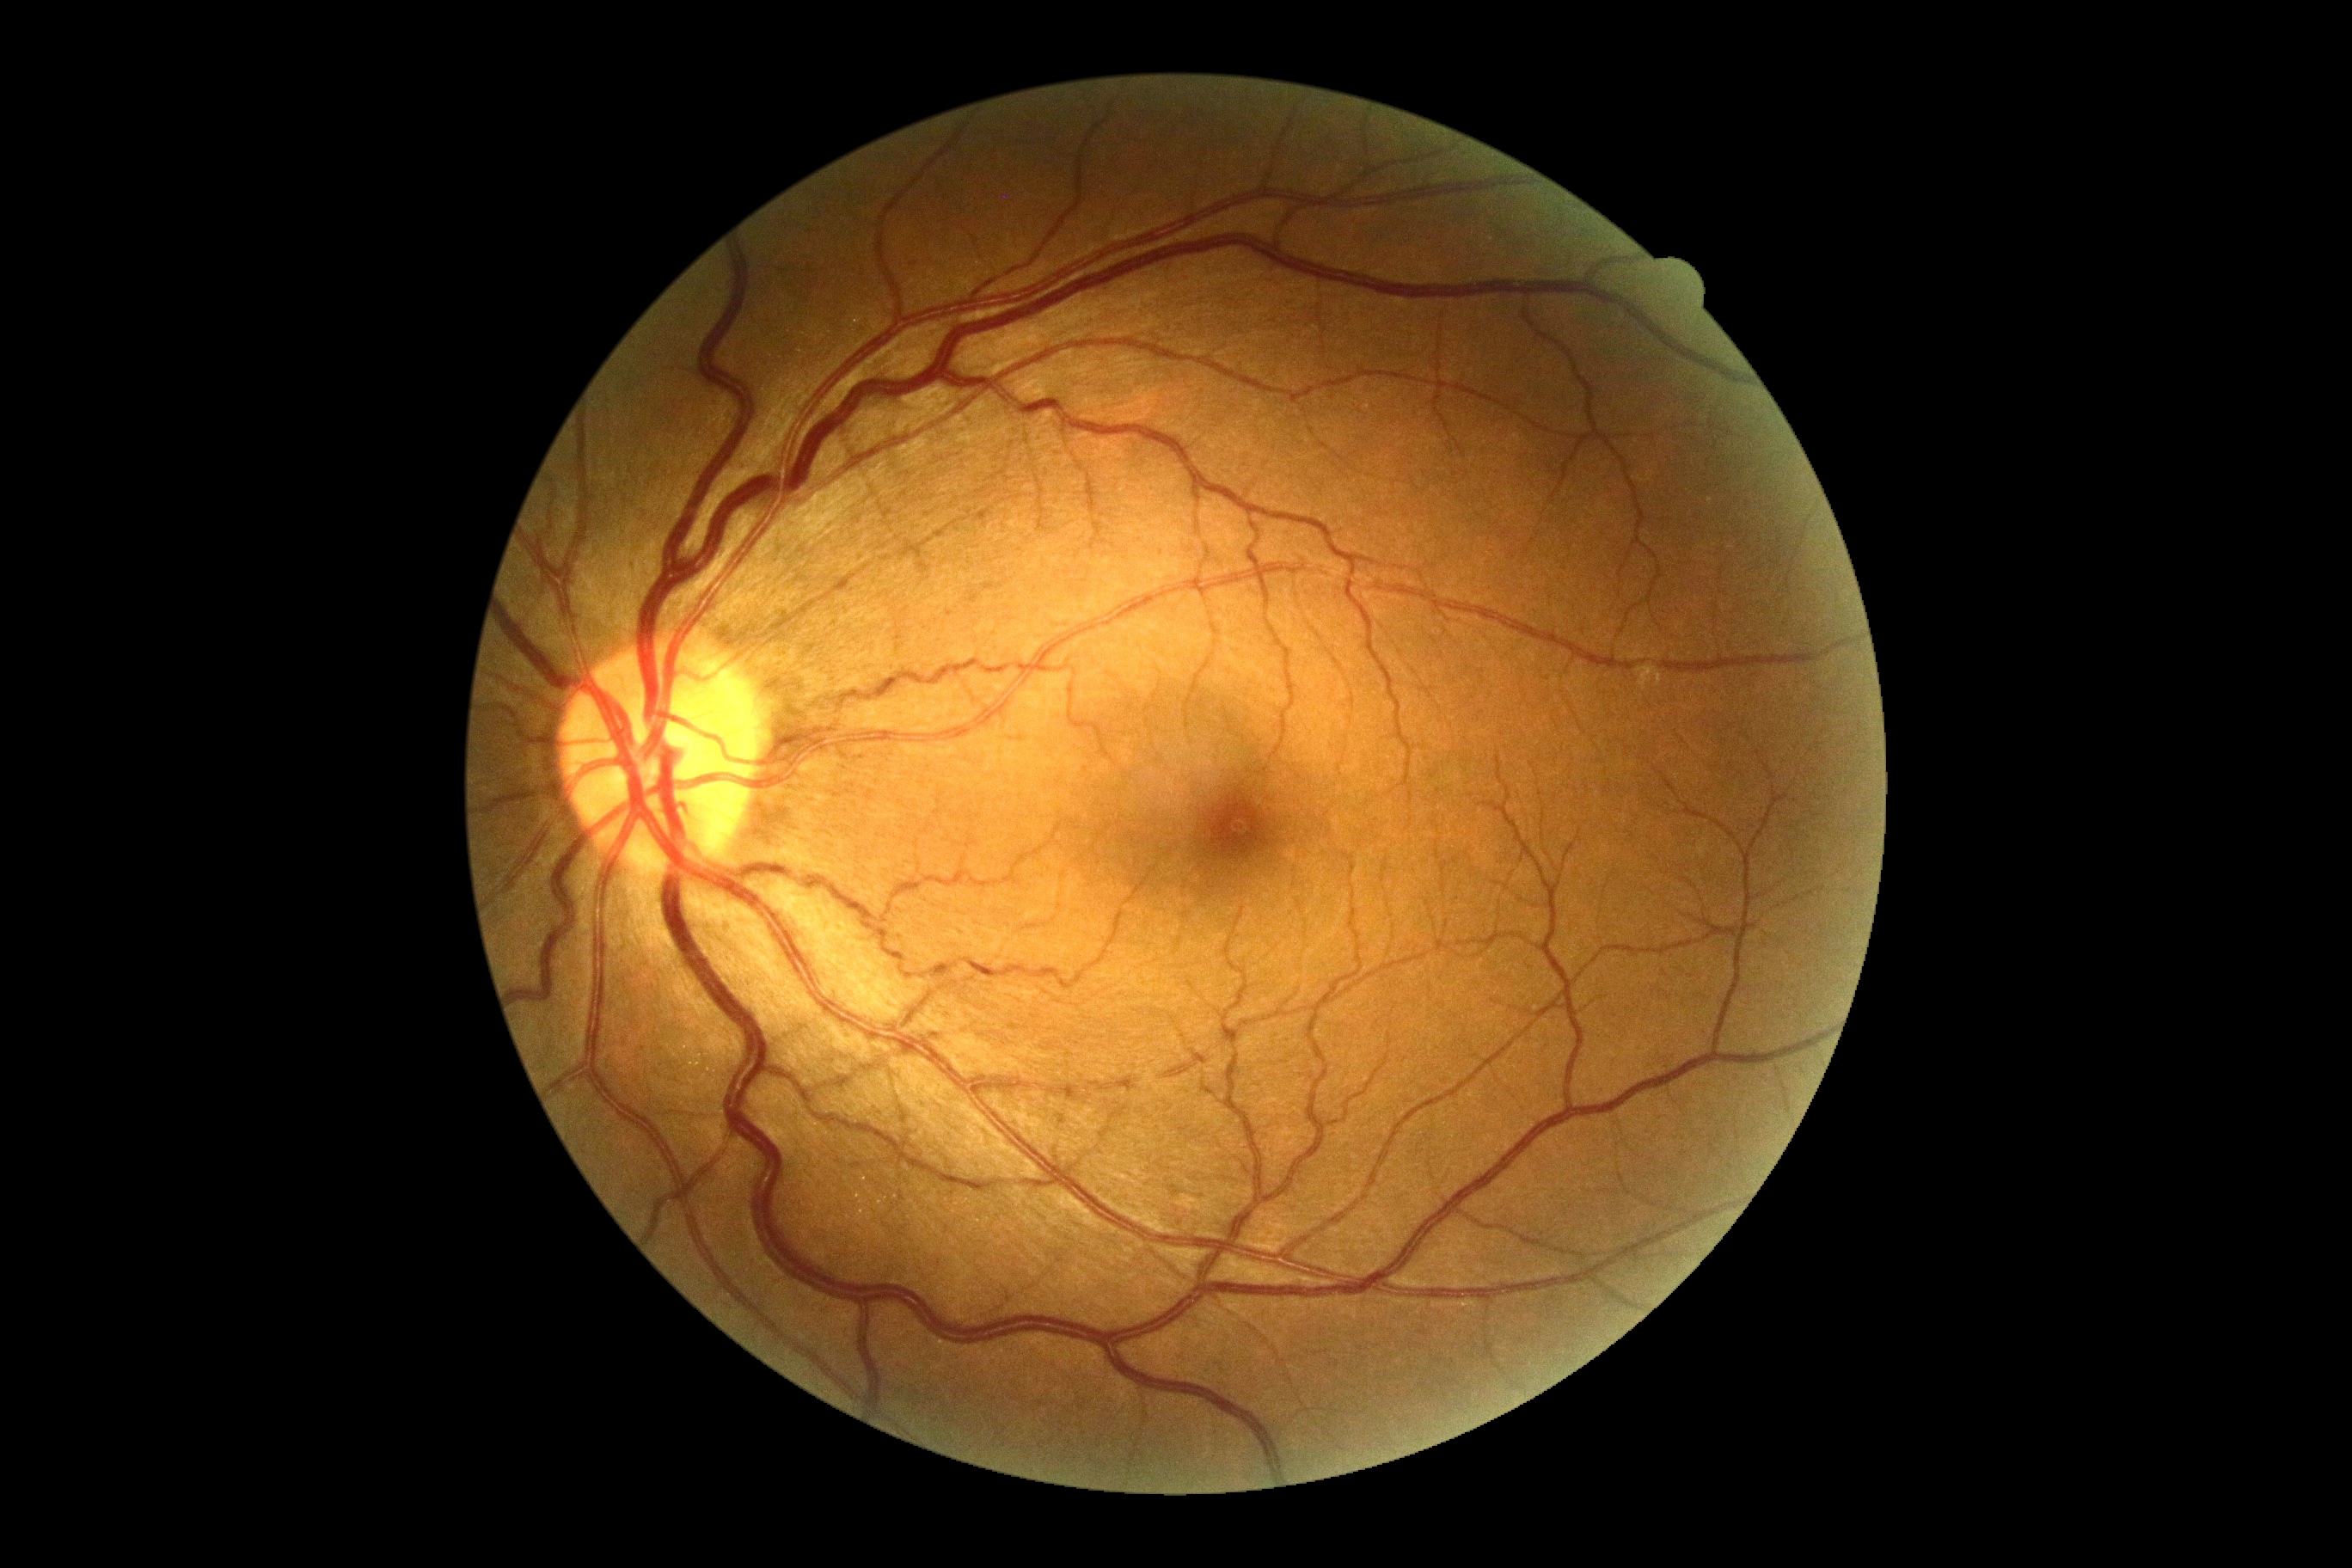
diabetic retinopathy severity = grade 0 (no apparent retinopathy)